50° field of view, CFP, 1932x1932:
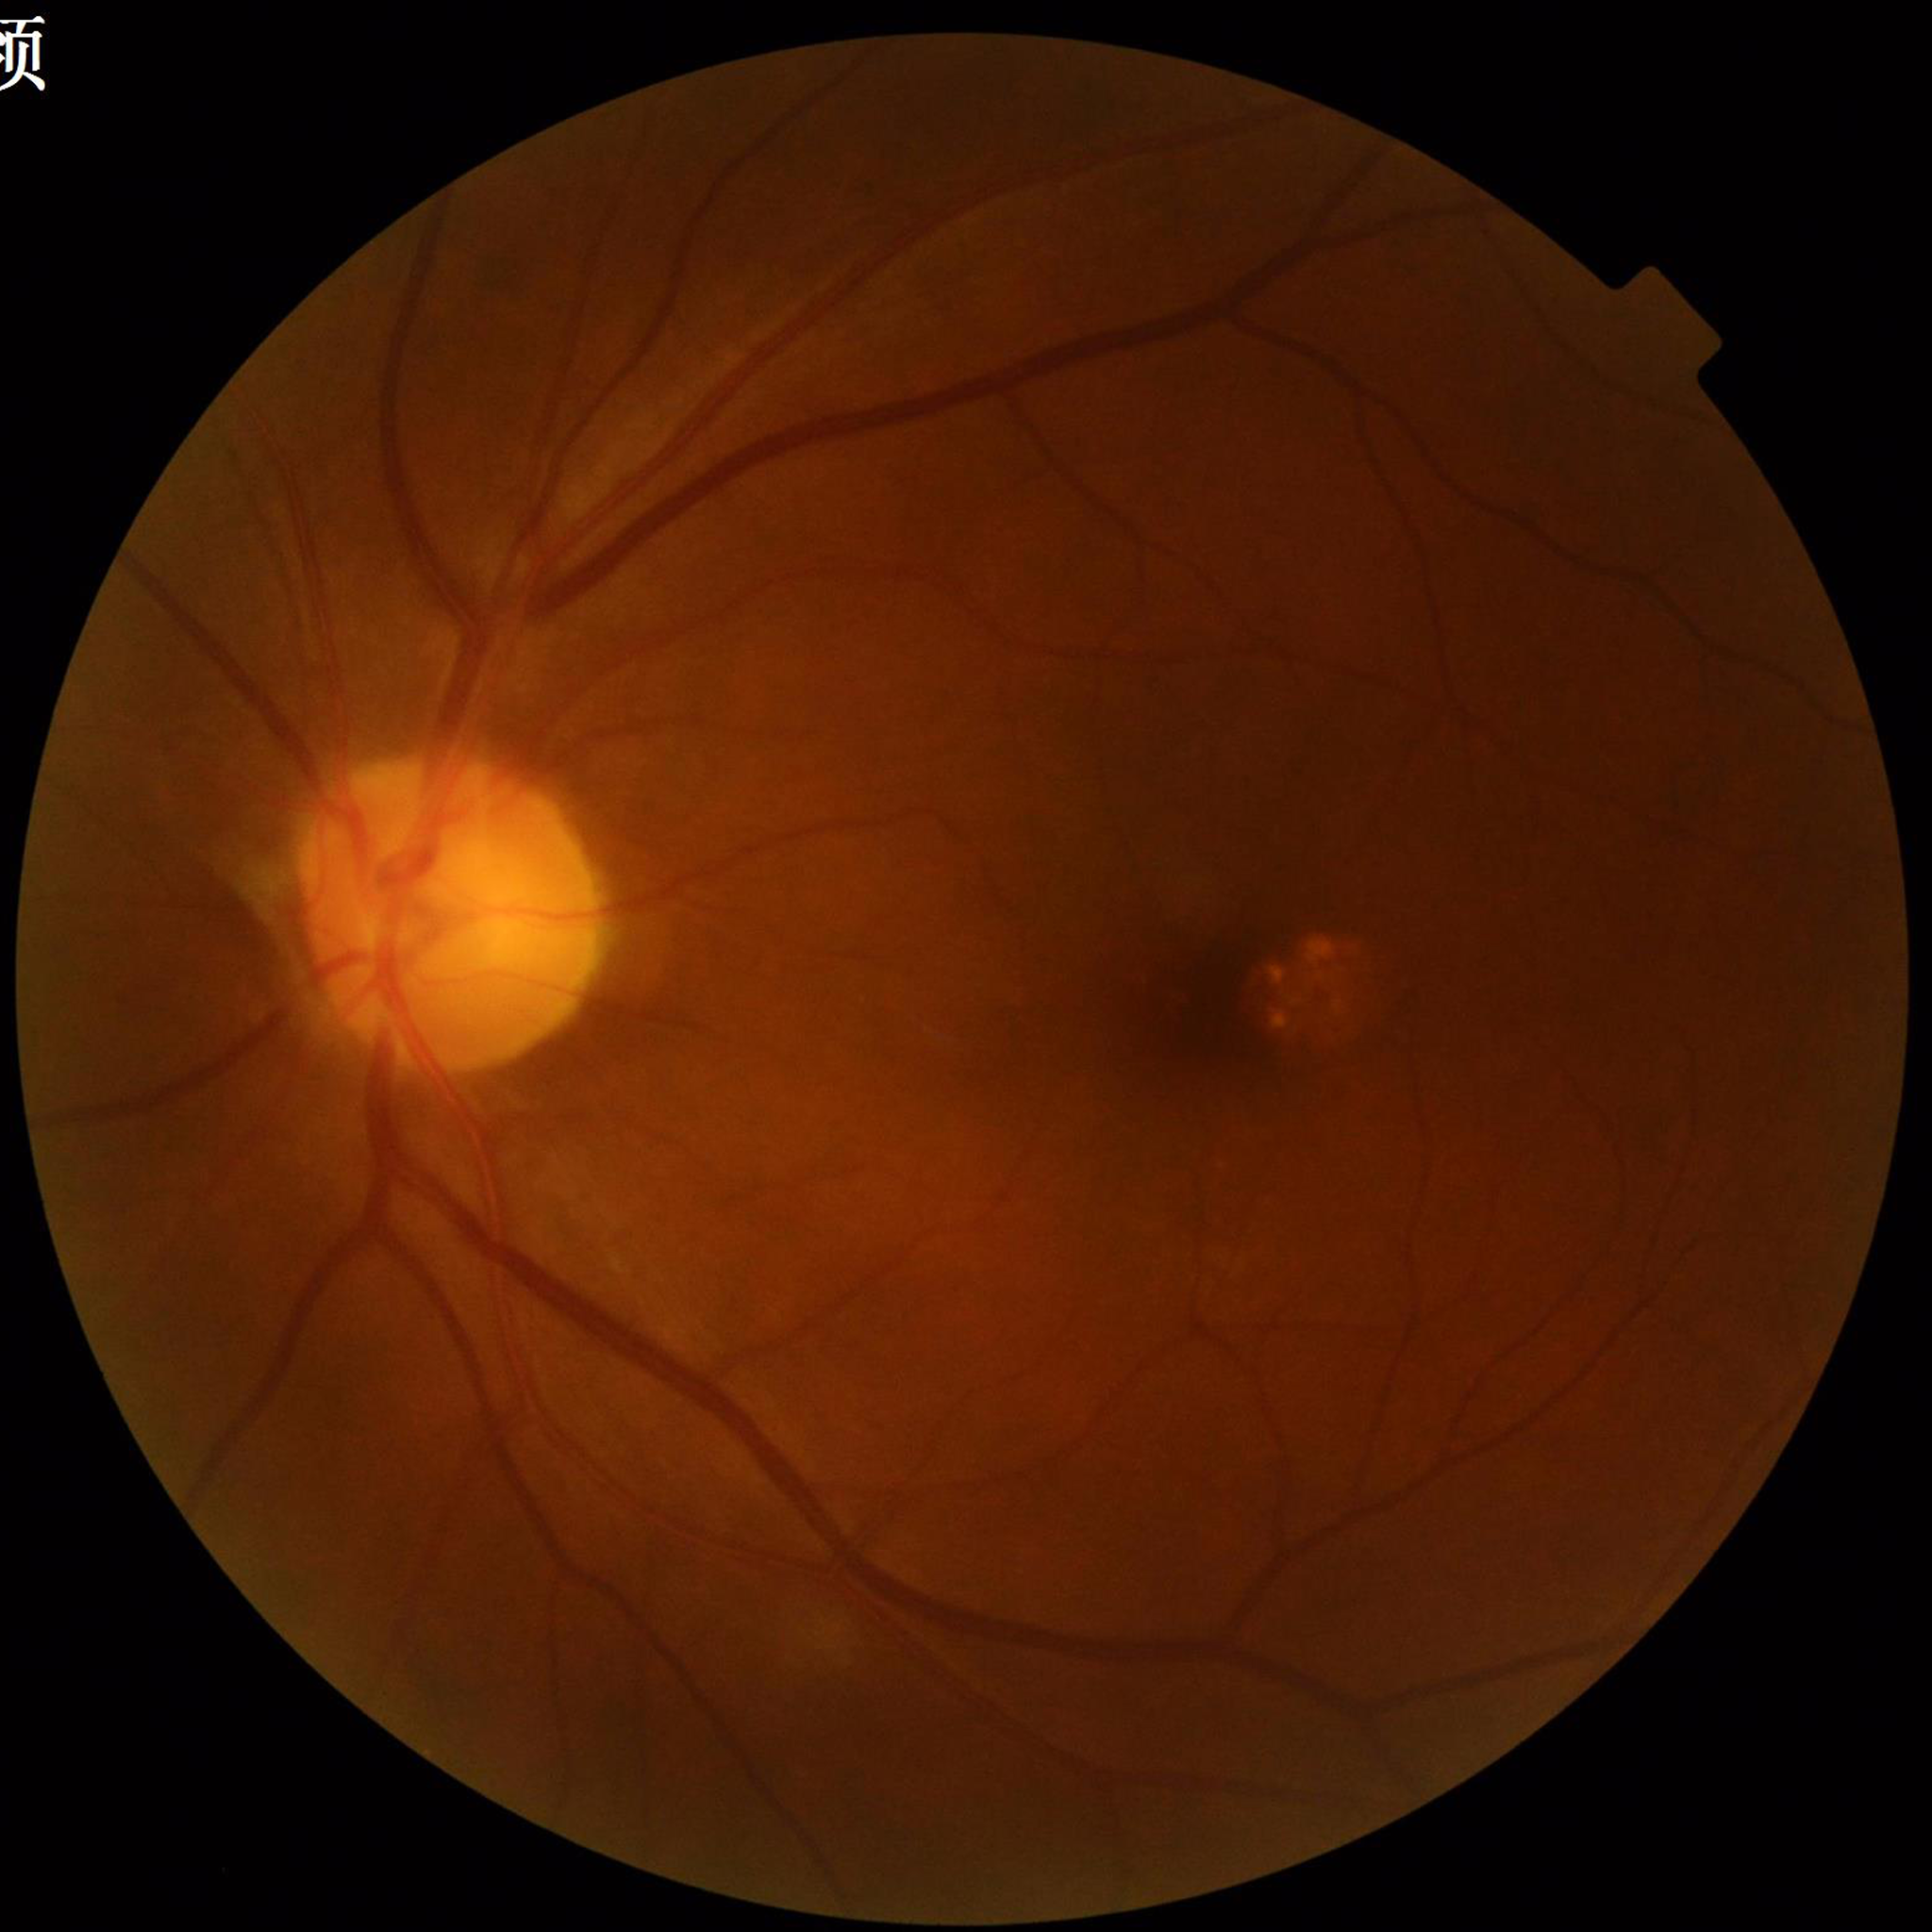
The patient was diagnosed with diabetic retinopathy.
Quality: good.